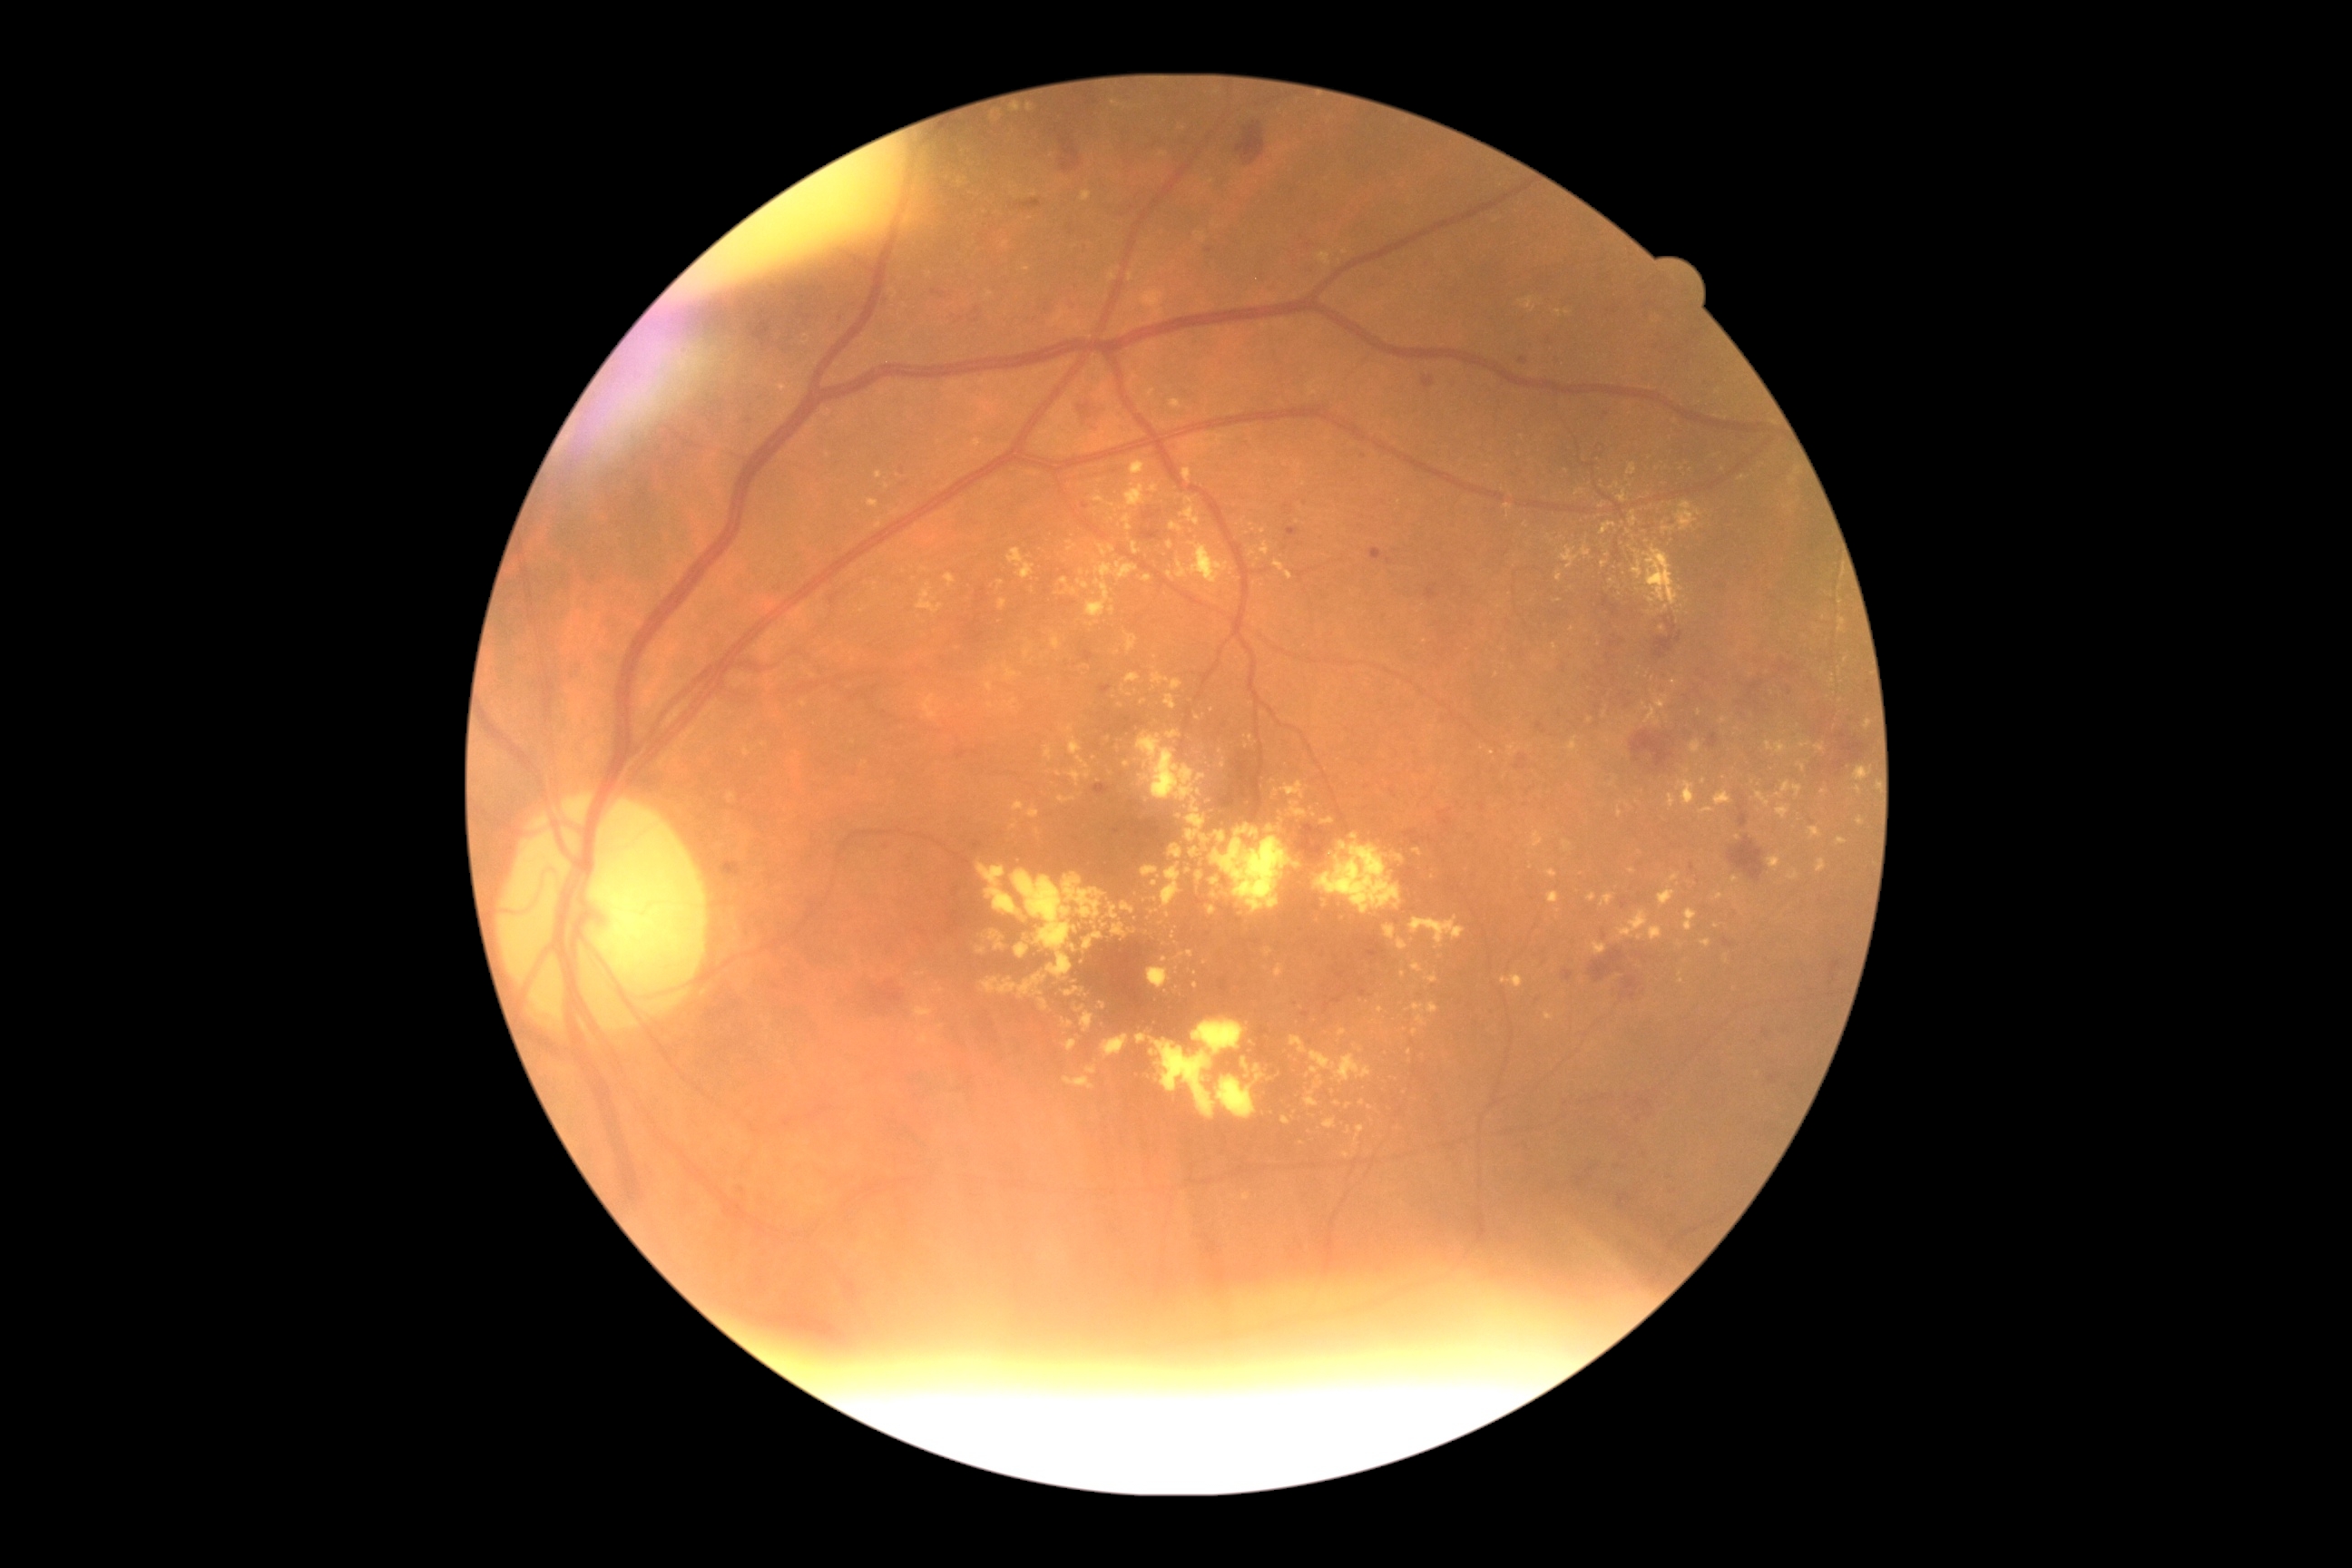
partial: true
dr_grade: 2
lesions:
  ex:
    - left=1132, top=544, right=1141, bottom=556
    - left=923, top=694, right=937, bottom=720
    - left=1068, top=738, right=1083, bottom=756
    - left=1197, top=872, right=1204, bottom=881
    - left=1520, top=299, right=1534, bottom=309
    - left=1161, top=865, right=1181, bottom=908
    - left=1758, top=792, right=1770, bottom=807
    - left=1627, top=464, right=1638, bottom=476
    - left=1079, top=952, right=1083, bottom=965
    - left=1788, top=872, right=1799, bottom=881
    - left=1671, top=874, right=1680, bottom=883
  ex_small_approx:
    - <pt>1841,602</pt>
    - <pt>1213,710</pt>
    - <pt>1164,959</pt>
    - <pt>1742,479</pt>
    - <pt>1604,565</pt>
    - <pt>1716,456</pt>
    - <pt>1073,949</pt>
    - <pt>1337,1103</pt>